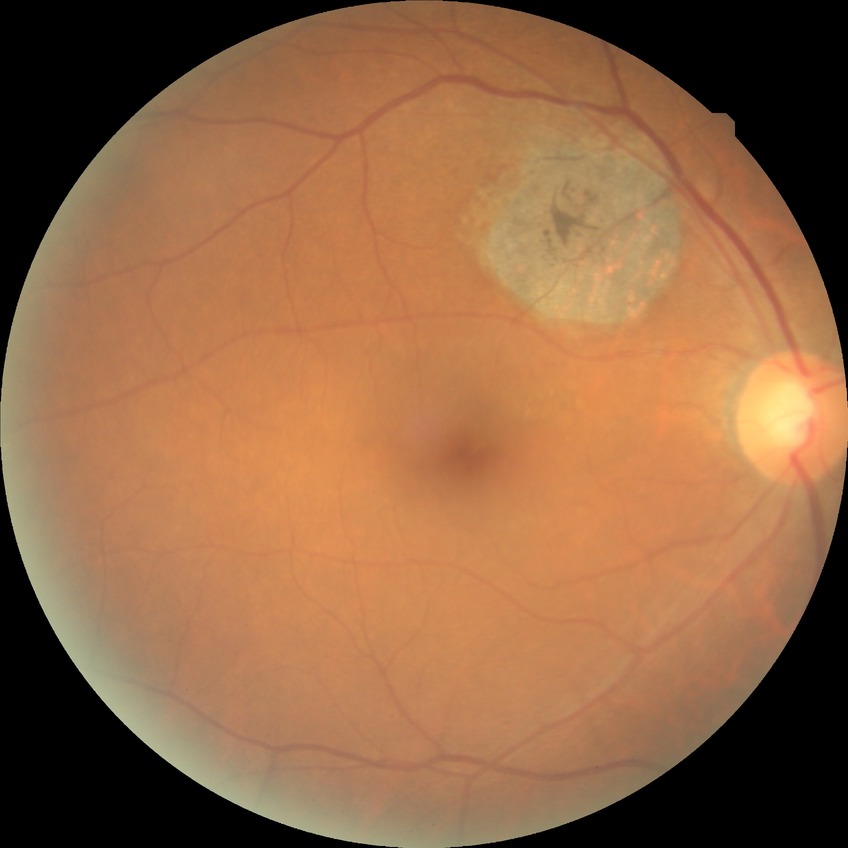
No apparent diabetic retinopathy. Davis stage: NDR.